Nonmydriatic fundus photograph. Retinal fundus photograph. FOV: 45 degrees: 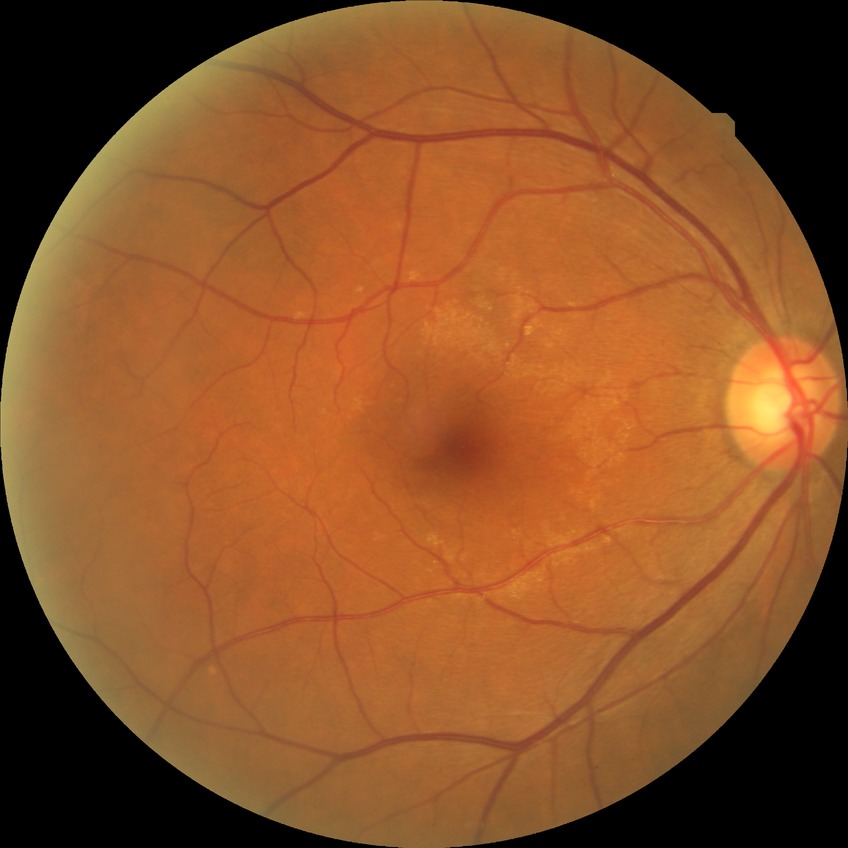

Diabetic retinopathy (DR) is NDR (no diabetic retinopathy).